FOV: 45 degrees, 2184 x 1682 pixels, retinal fundus photograph: 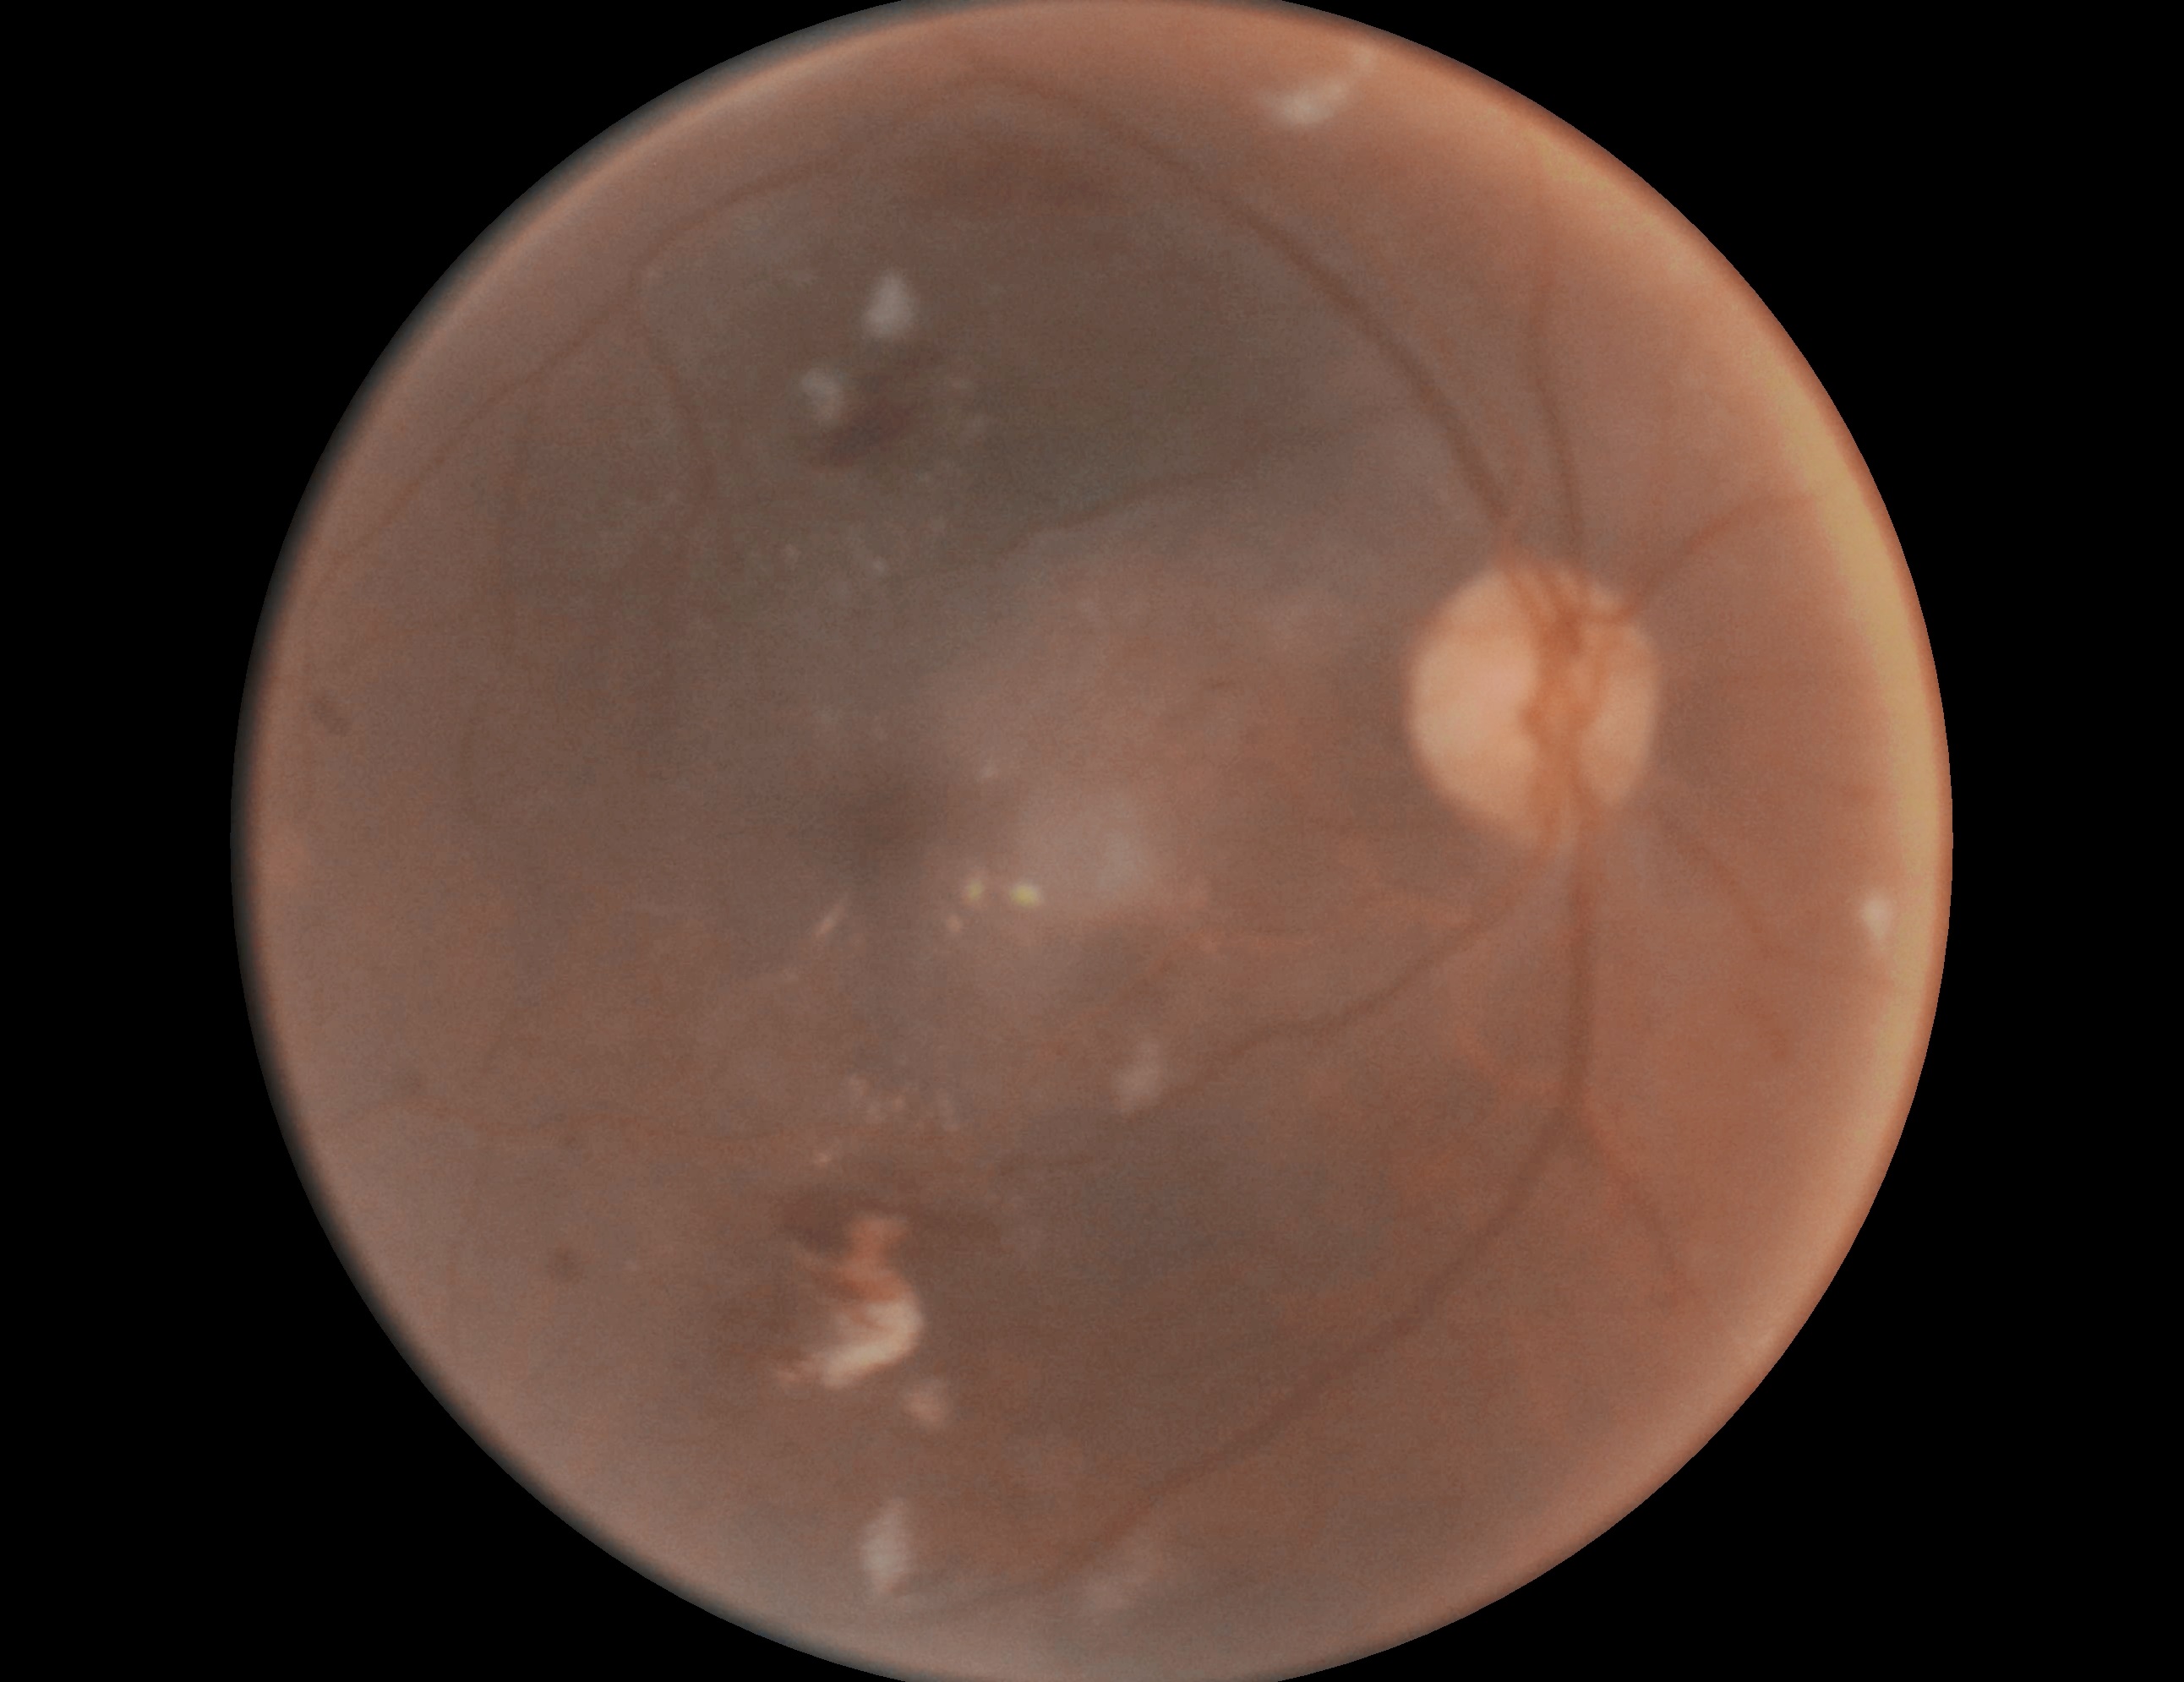
DR stage is grade 2 (moderate NPDR).